2352 x 1568 pixels — 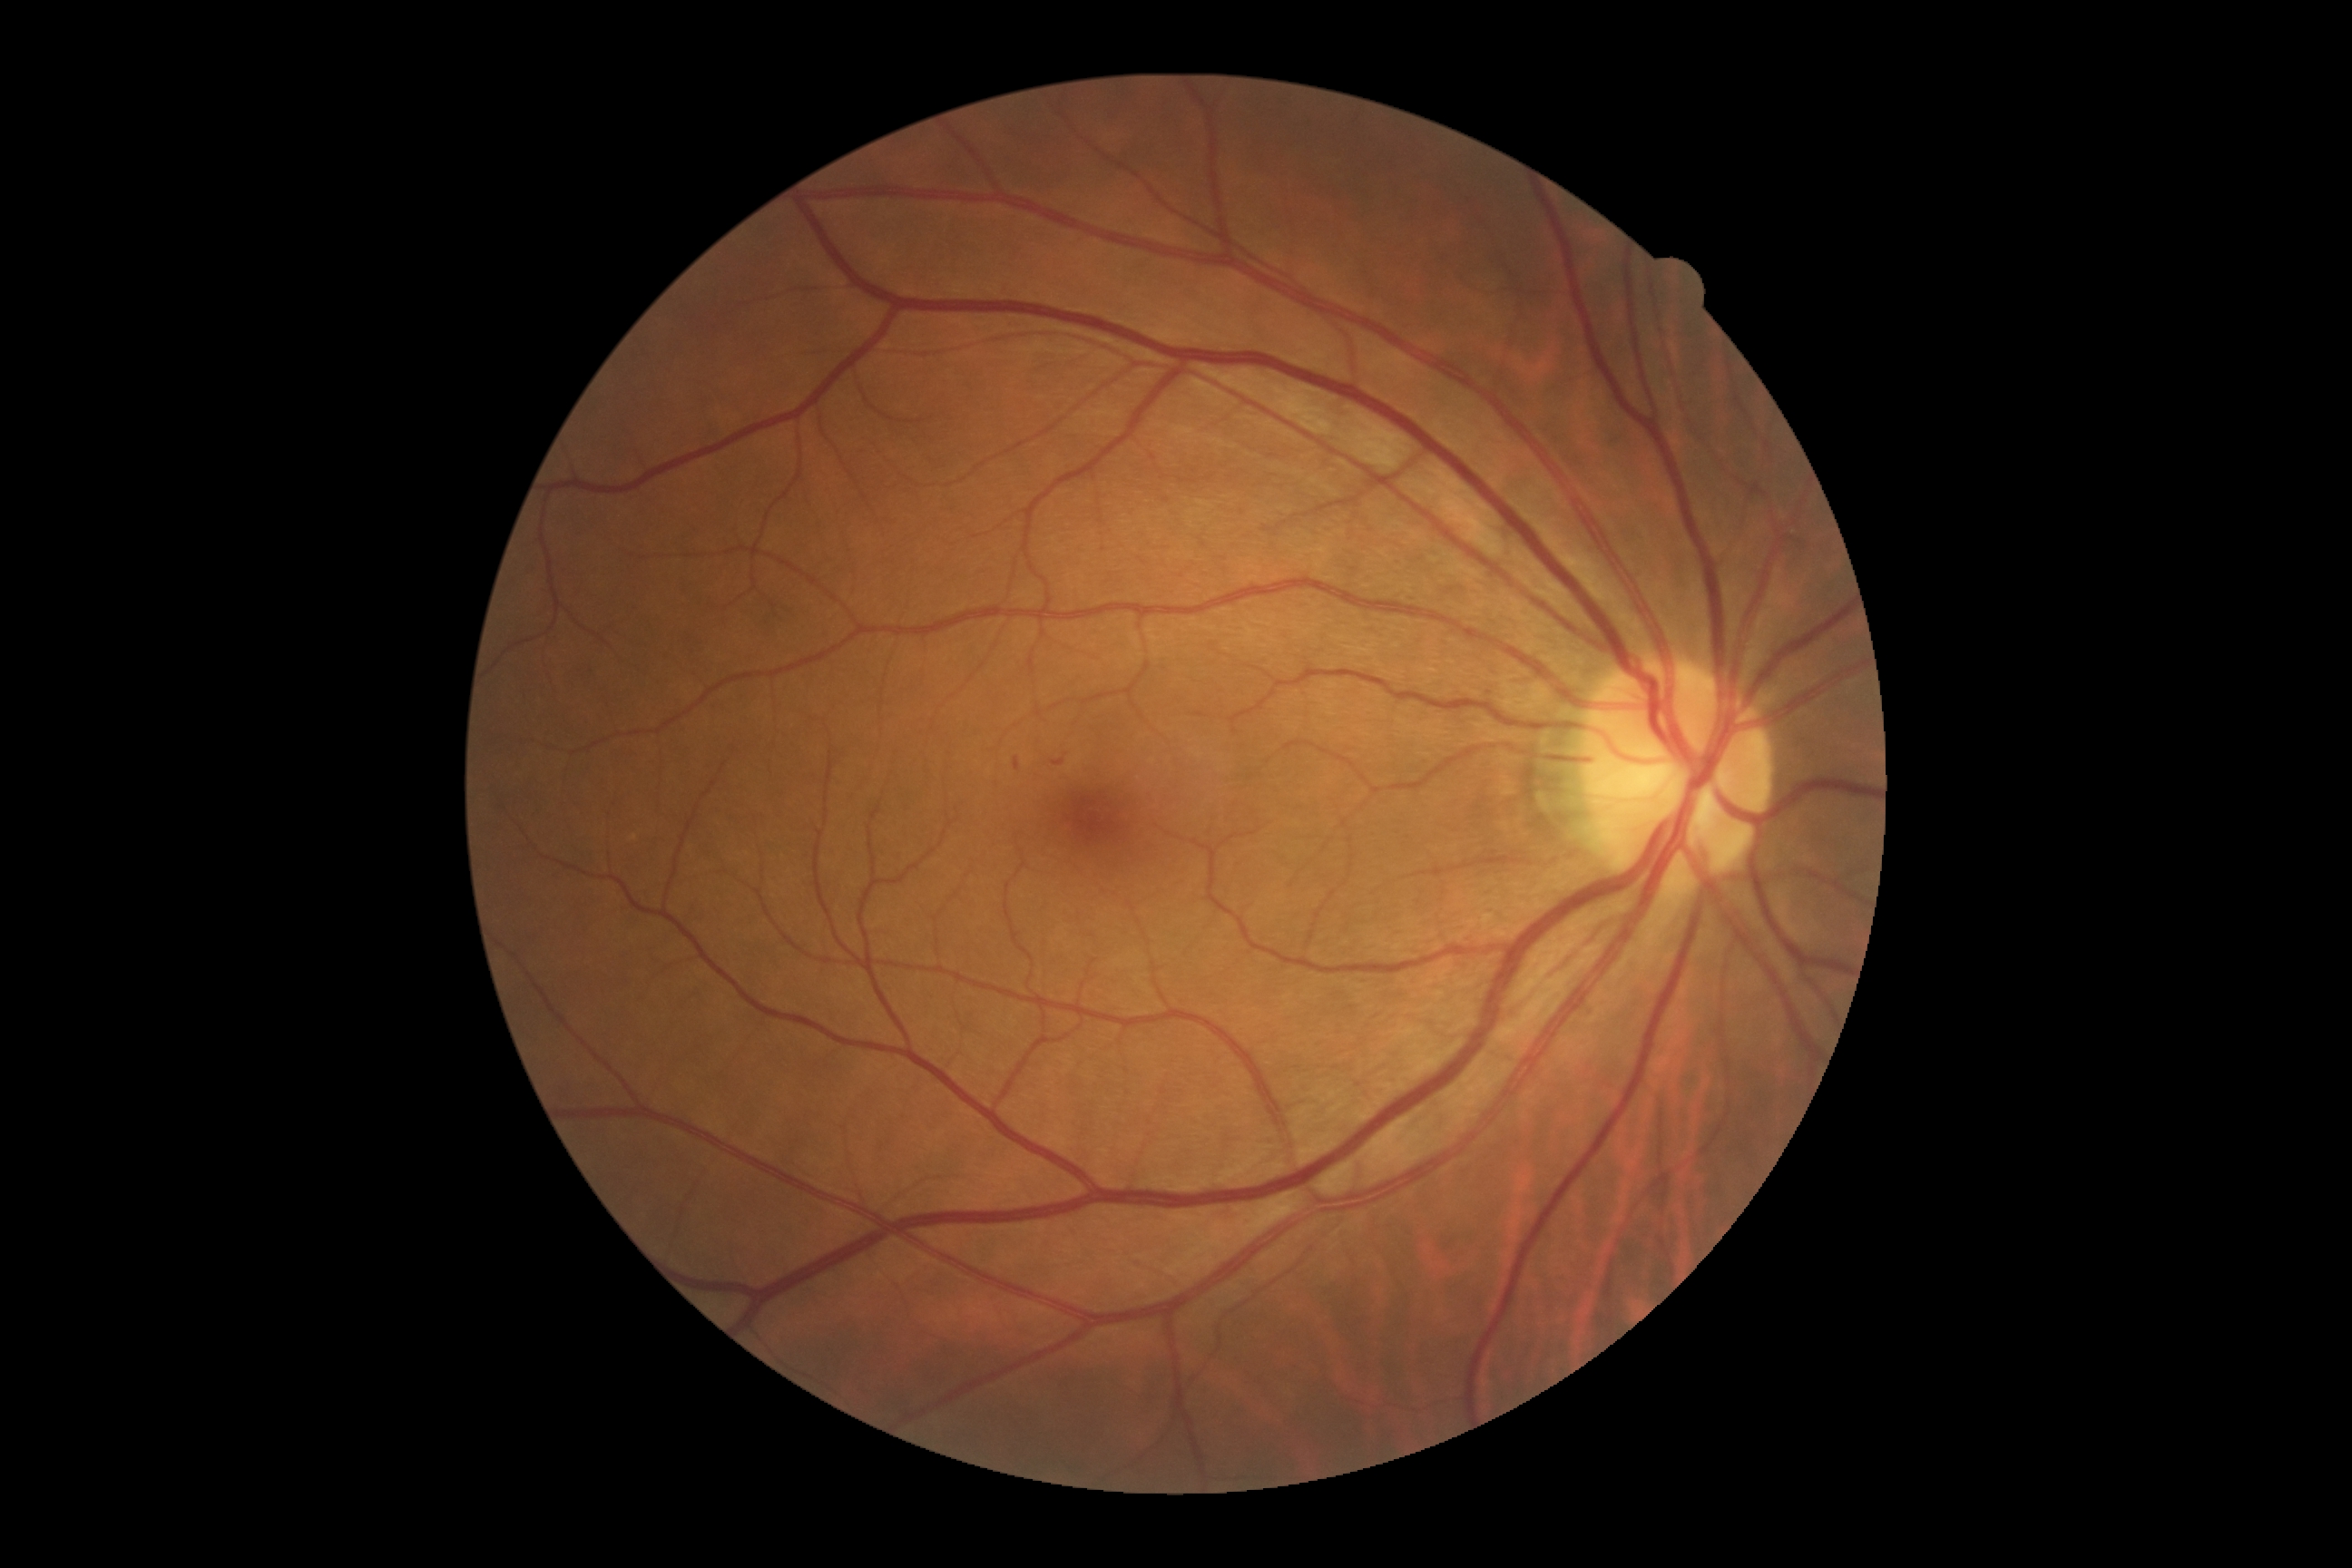
diabetic retinopathy (DR): mild non-proliferative diabetic retinopathy (grade 1).